Color fundus image, FOV: 45 degrees: 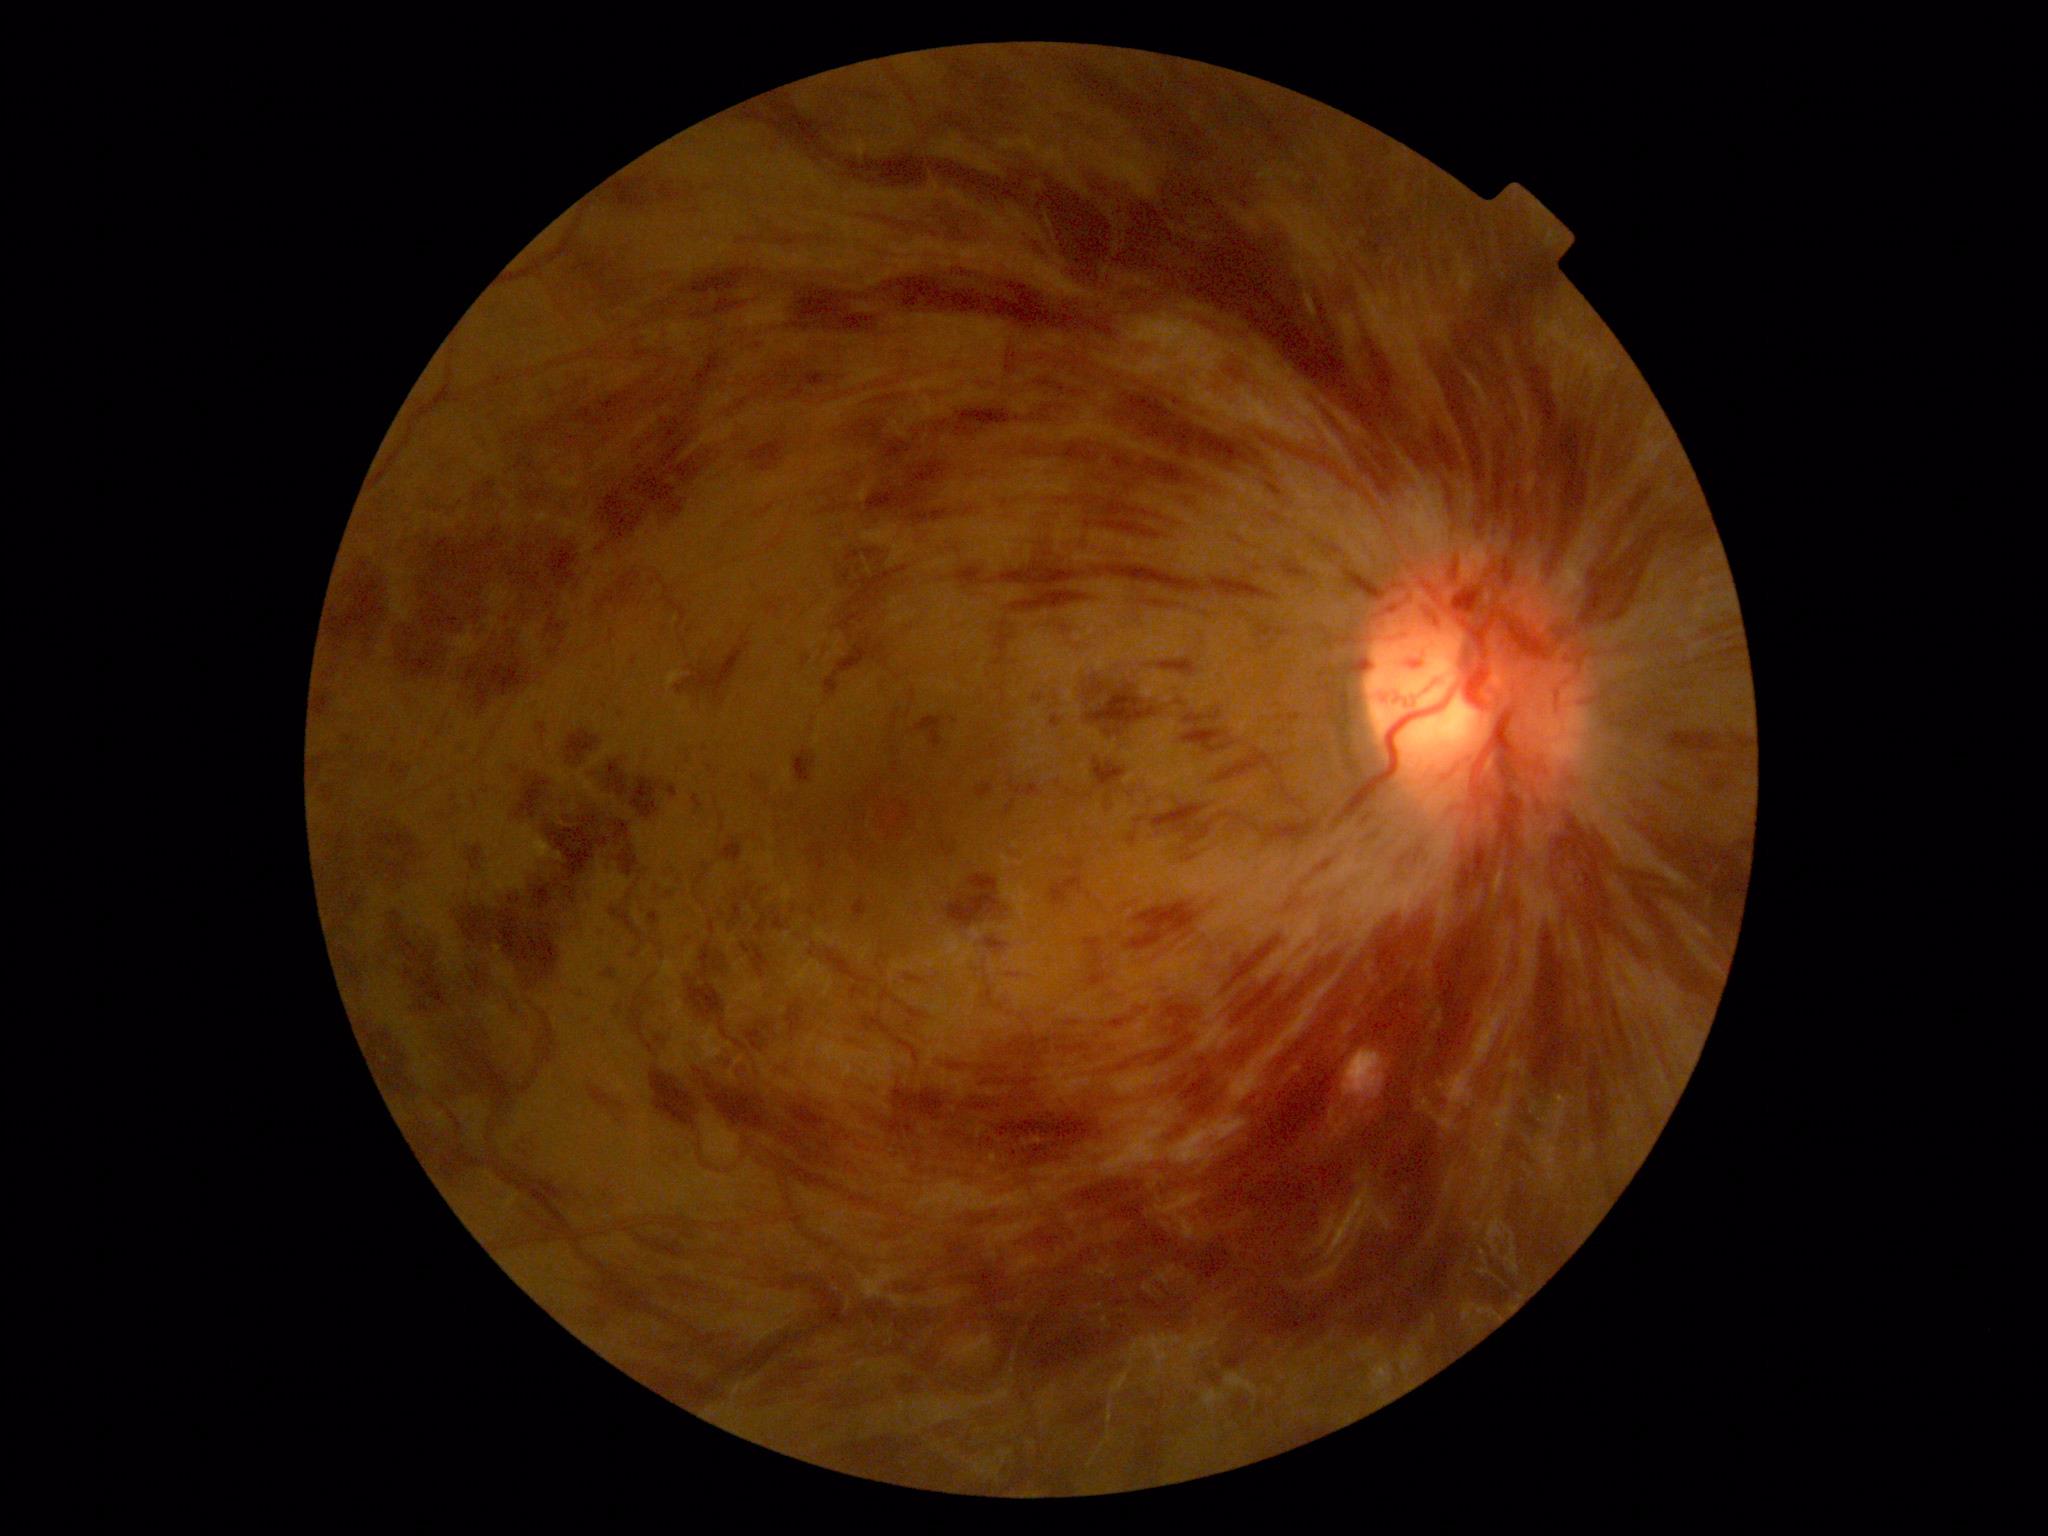 The retinopathy is classified as non-proliferative diabetic retinopathy. Diabetic retinopathy (DR): severe NPDR (grade 3).